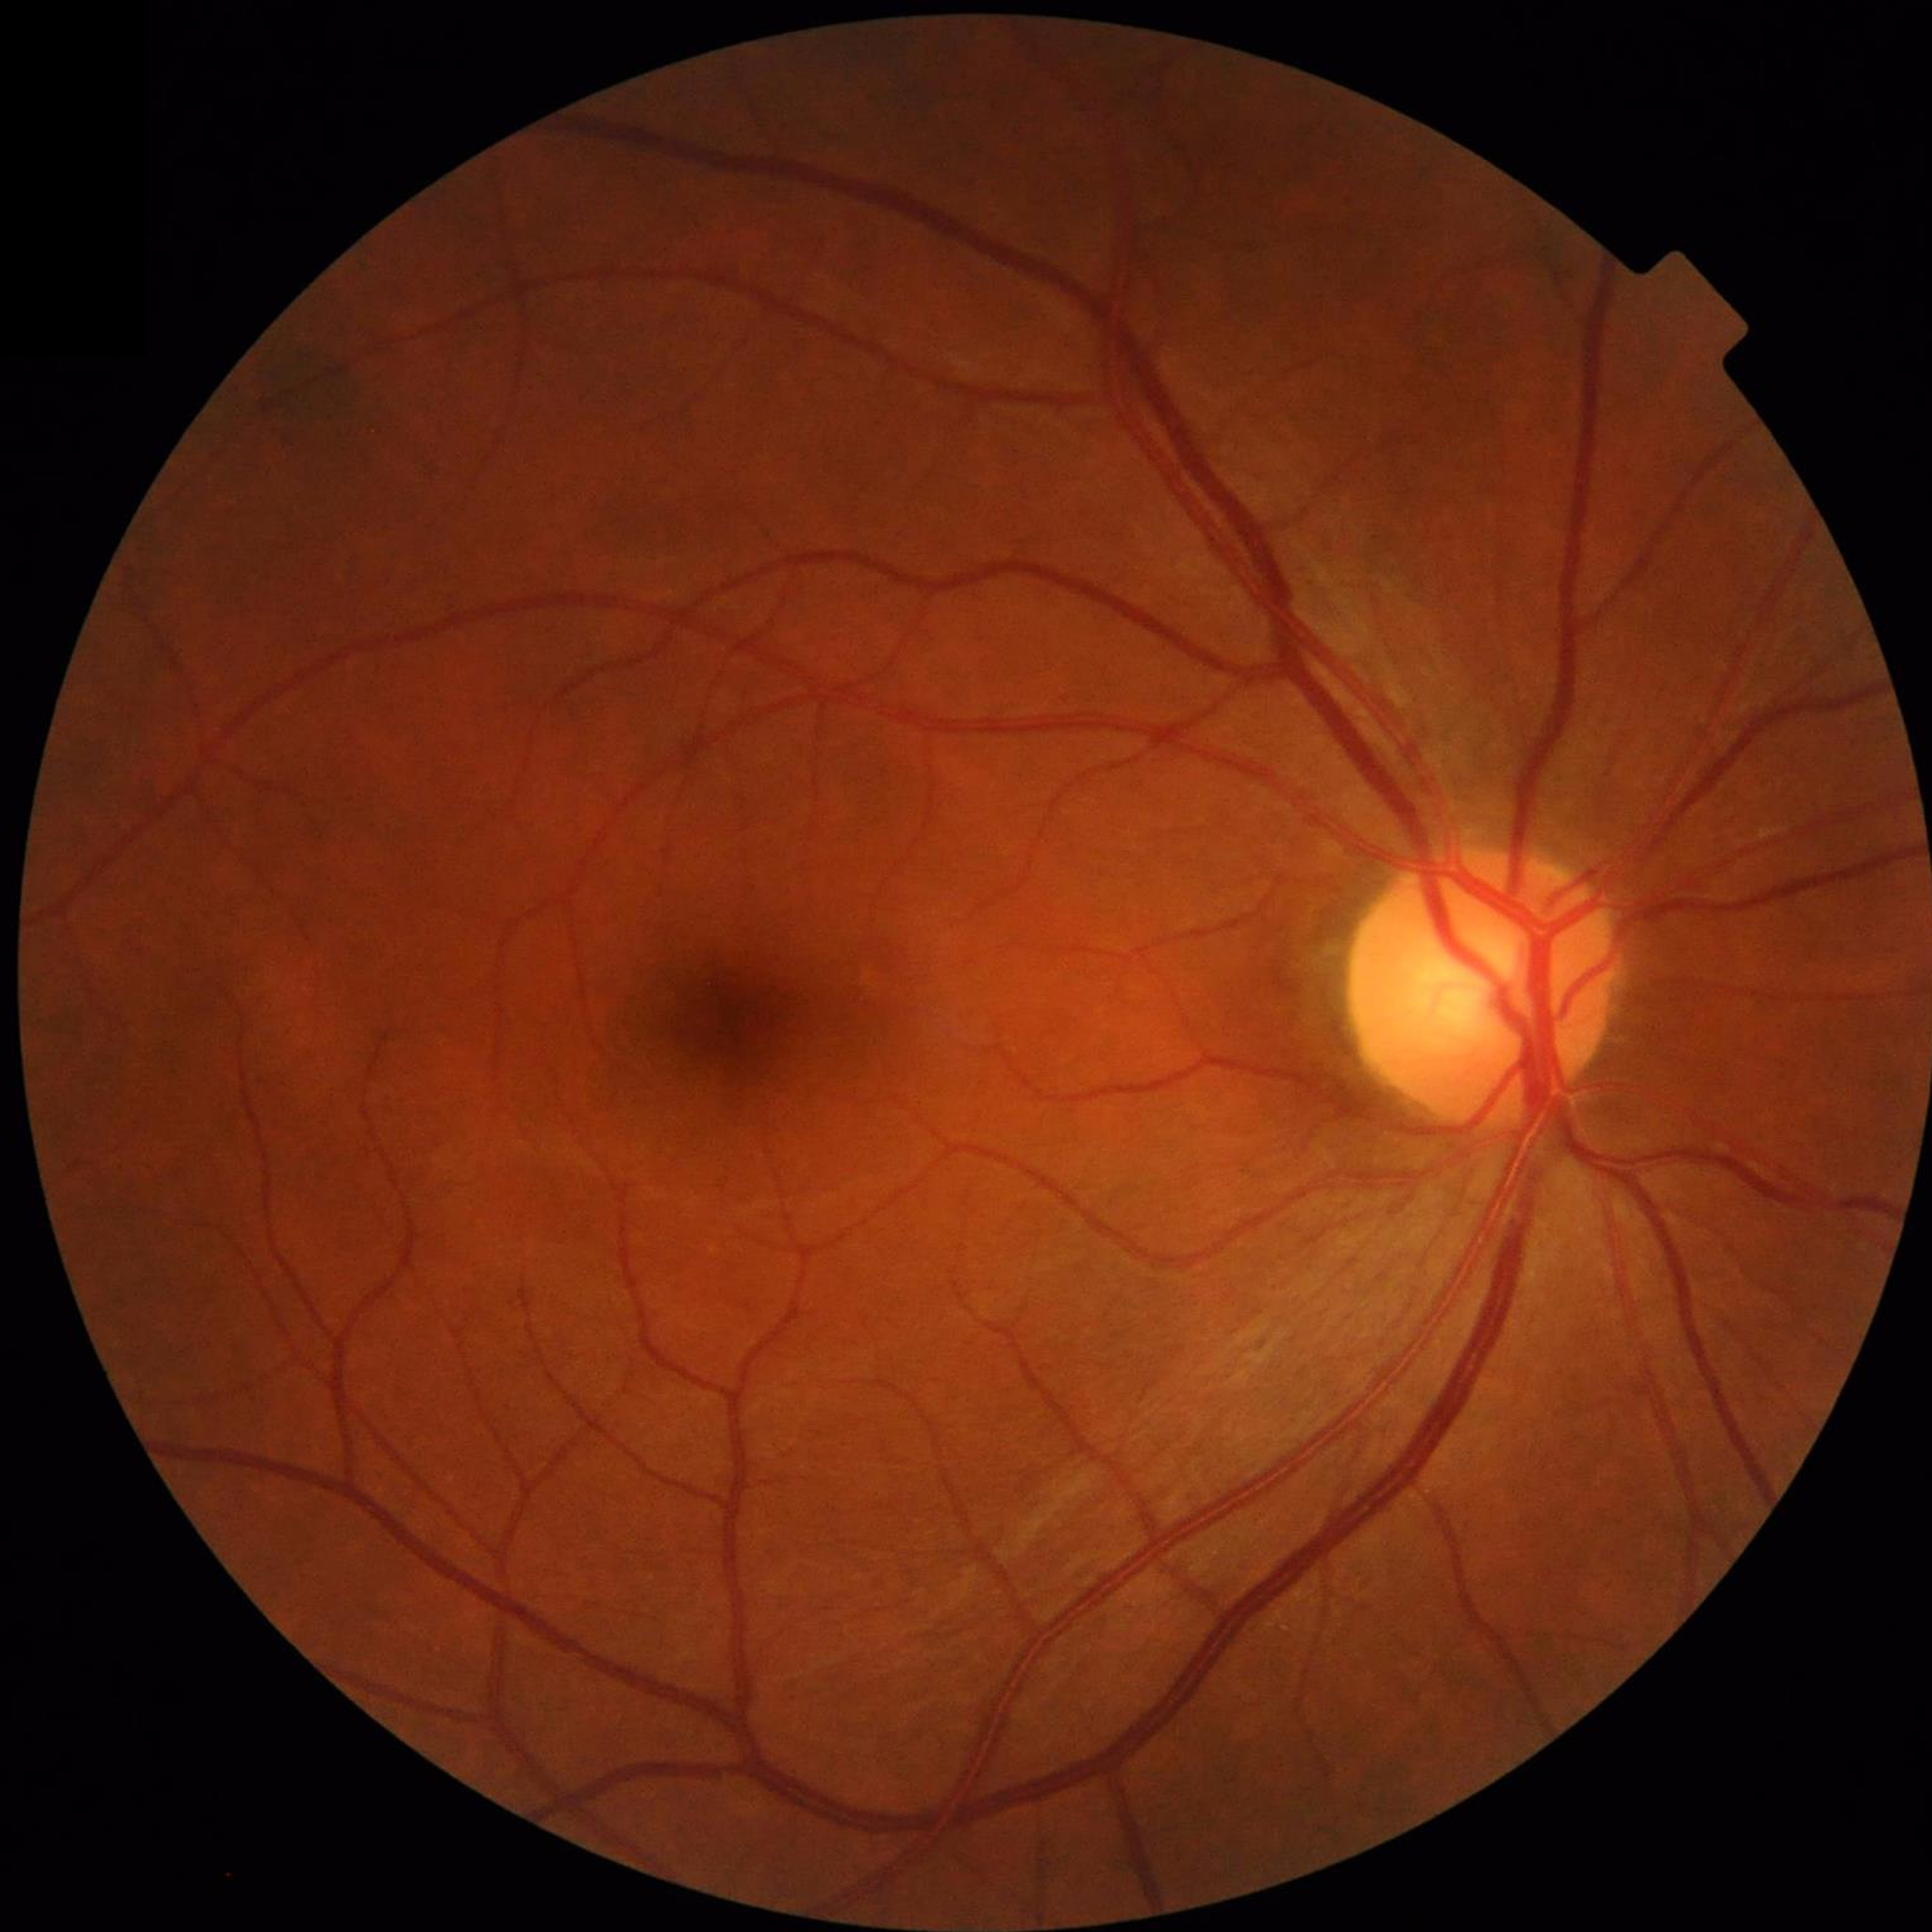
Quality assessment: contrast adequate, illumination and color satisfactory, no blur. Fundus image with no AMD, diabetic retinopathy, or glaucomatous findings.